Color fundus image — 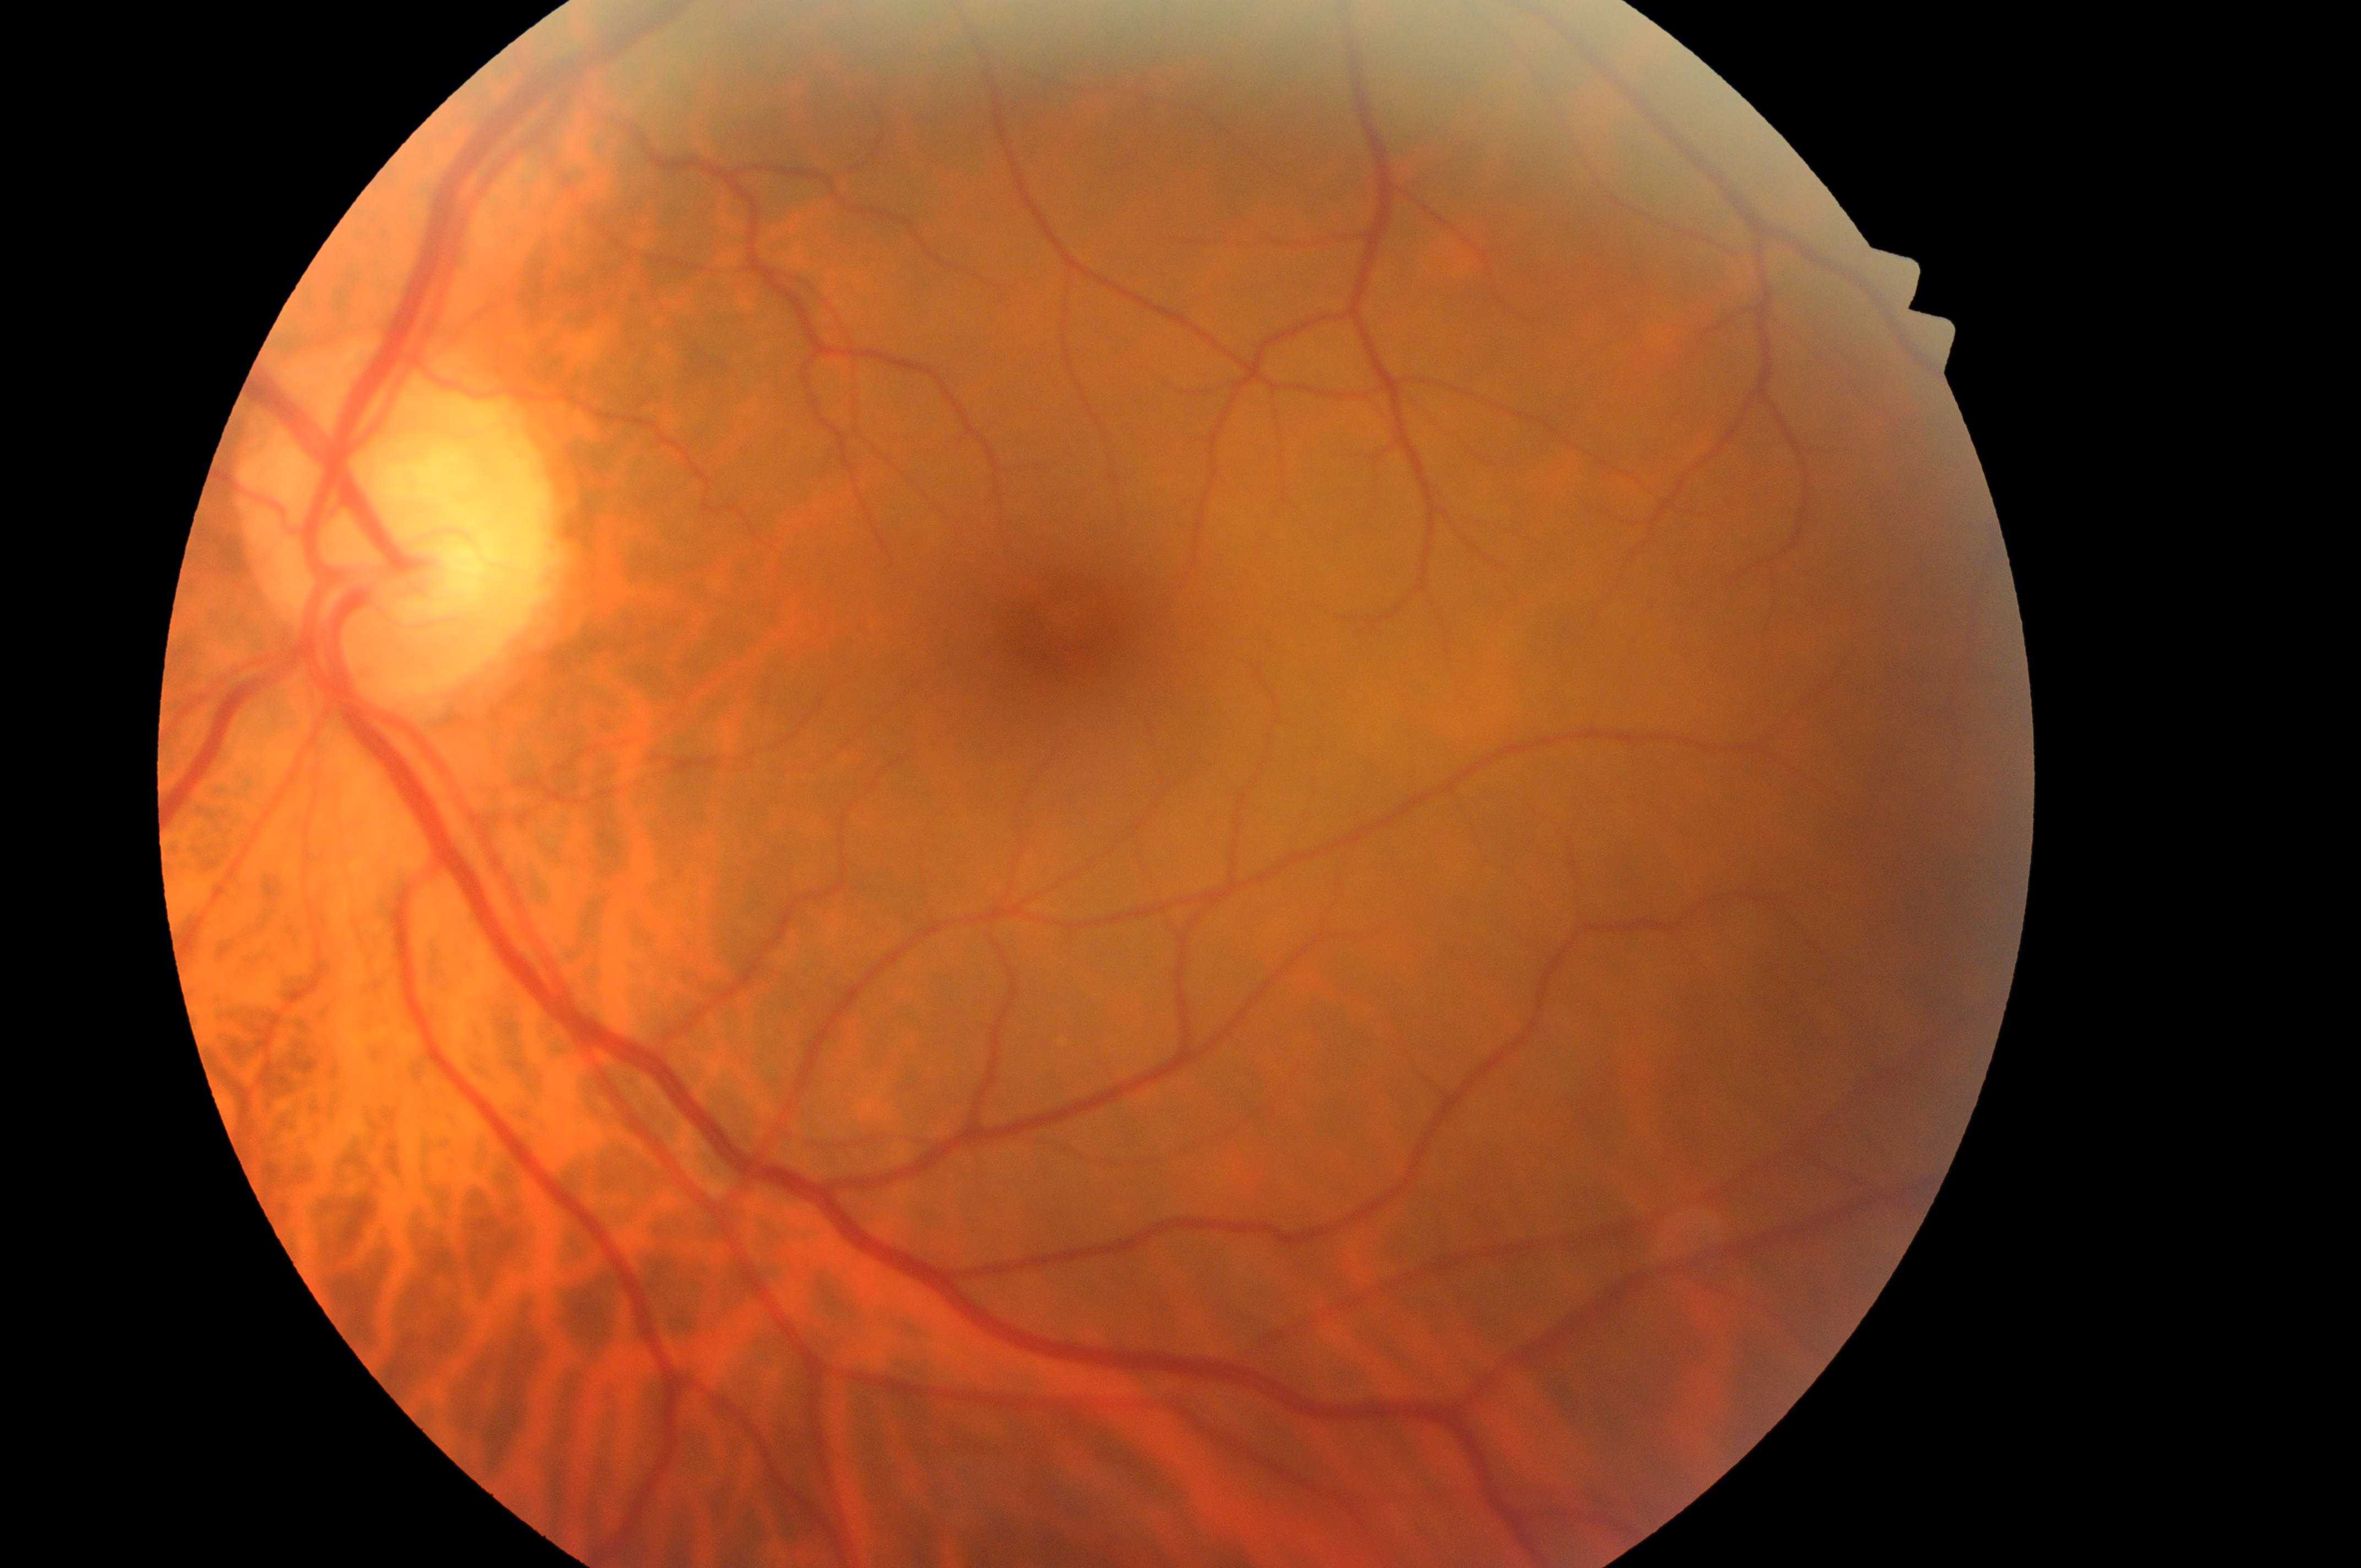

Fovea center: (1067,629). Risk of macular edema is grade 0 (no risk). No apparent diabetic retinopathy or macular edema. Retinopathy is grade 0 (no apparent retinopathy). This is the OS. The optic disc is at (391,525).